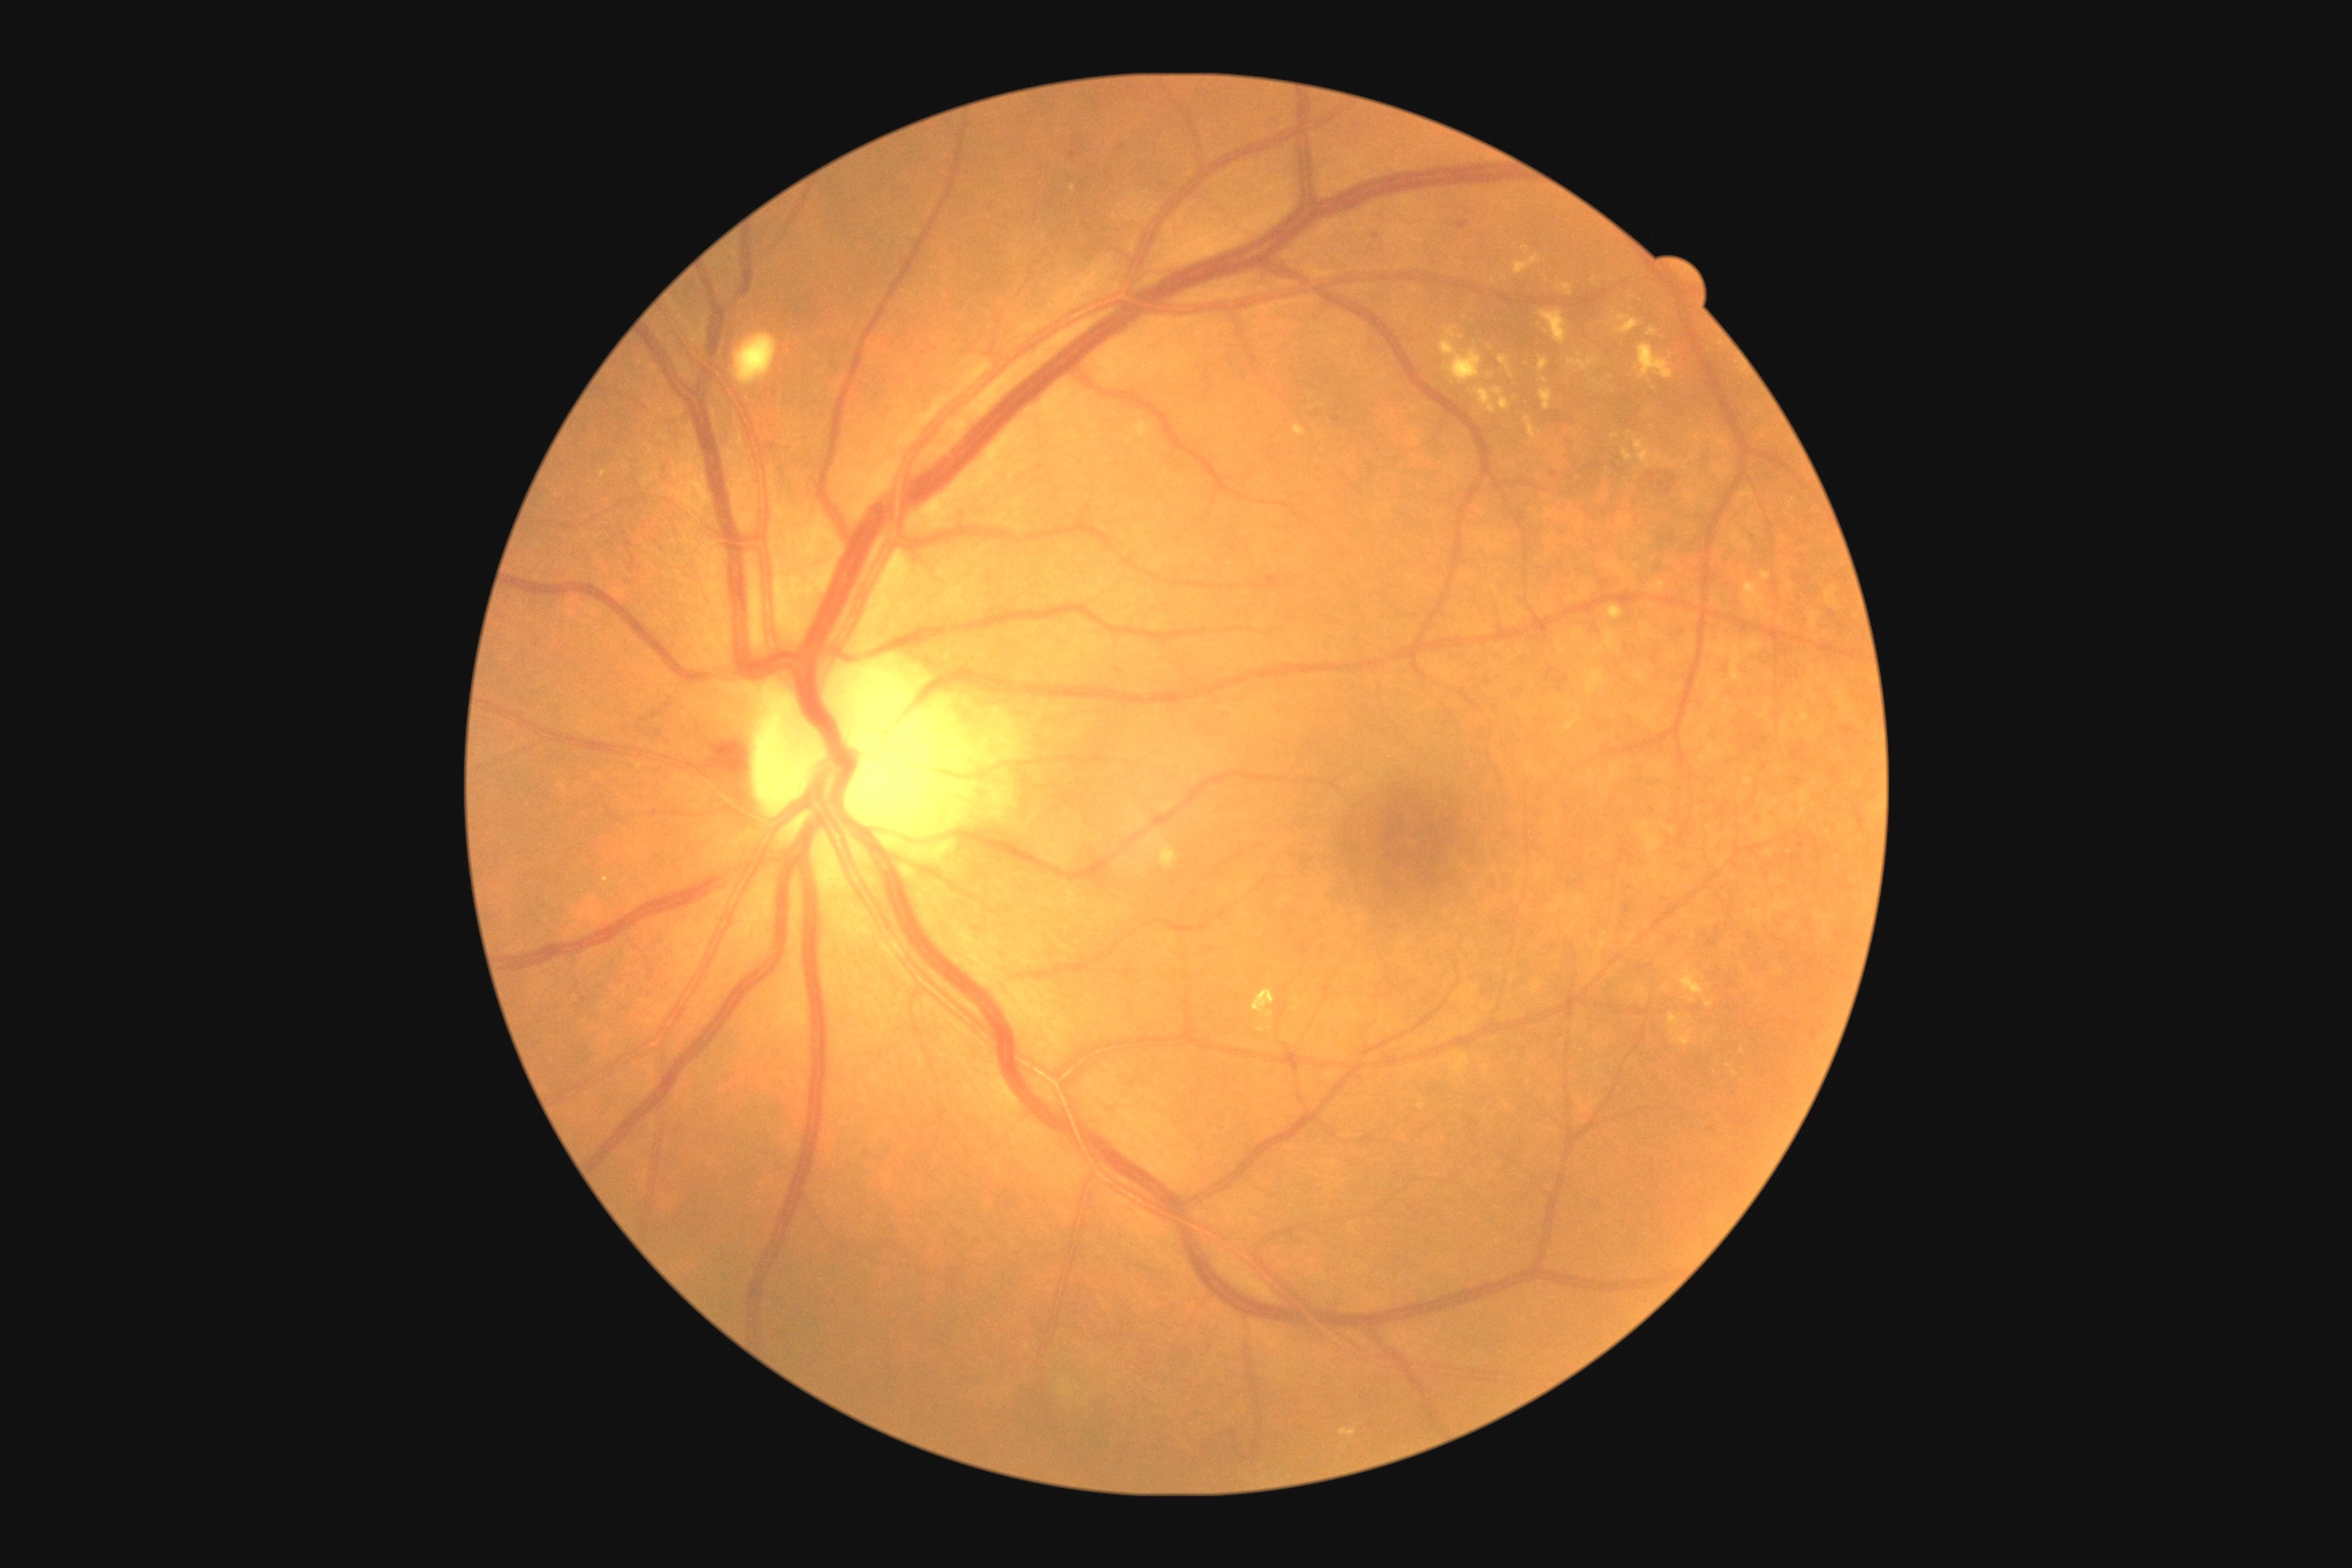

retinopathy grade@2.